848 x 848 pixels. Acquired with a NIDEK AFC-230. Fundus photo. No pharmacologic dilation.
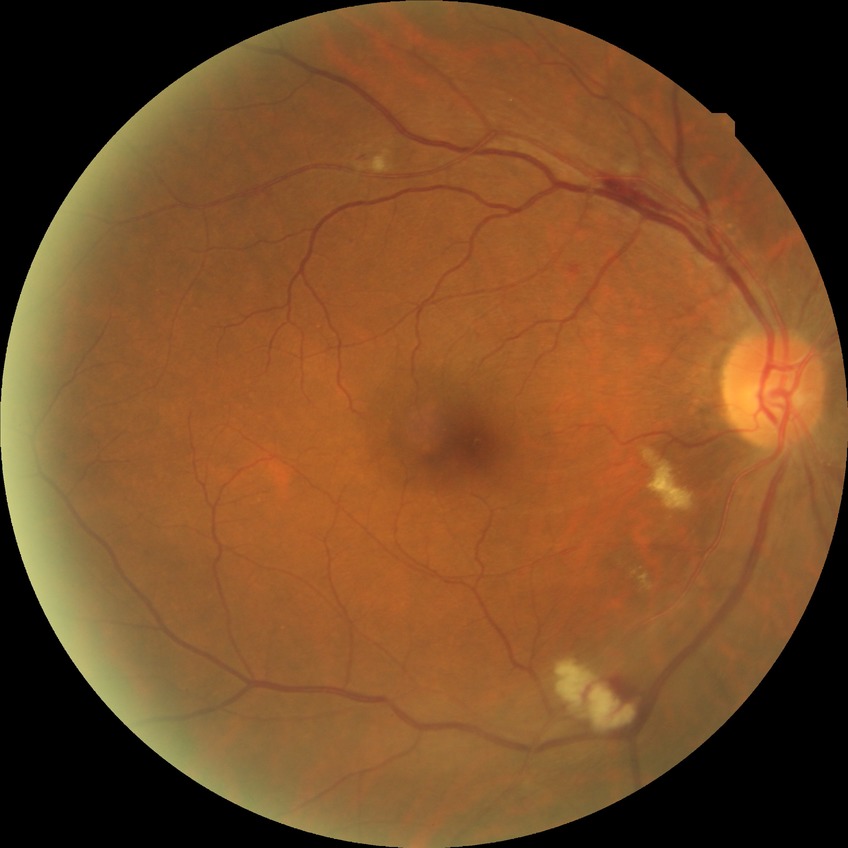

DR grade is PPDR.
Disease class: non-proliferative diabetic retinopathy.